45° field of view: 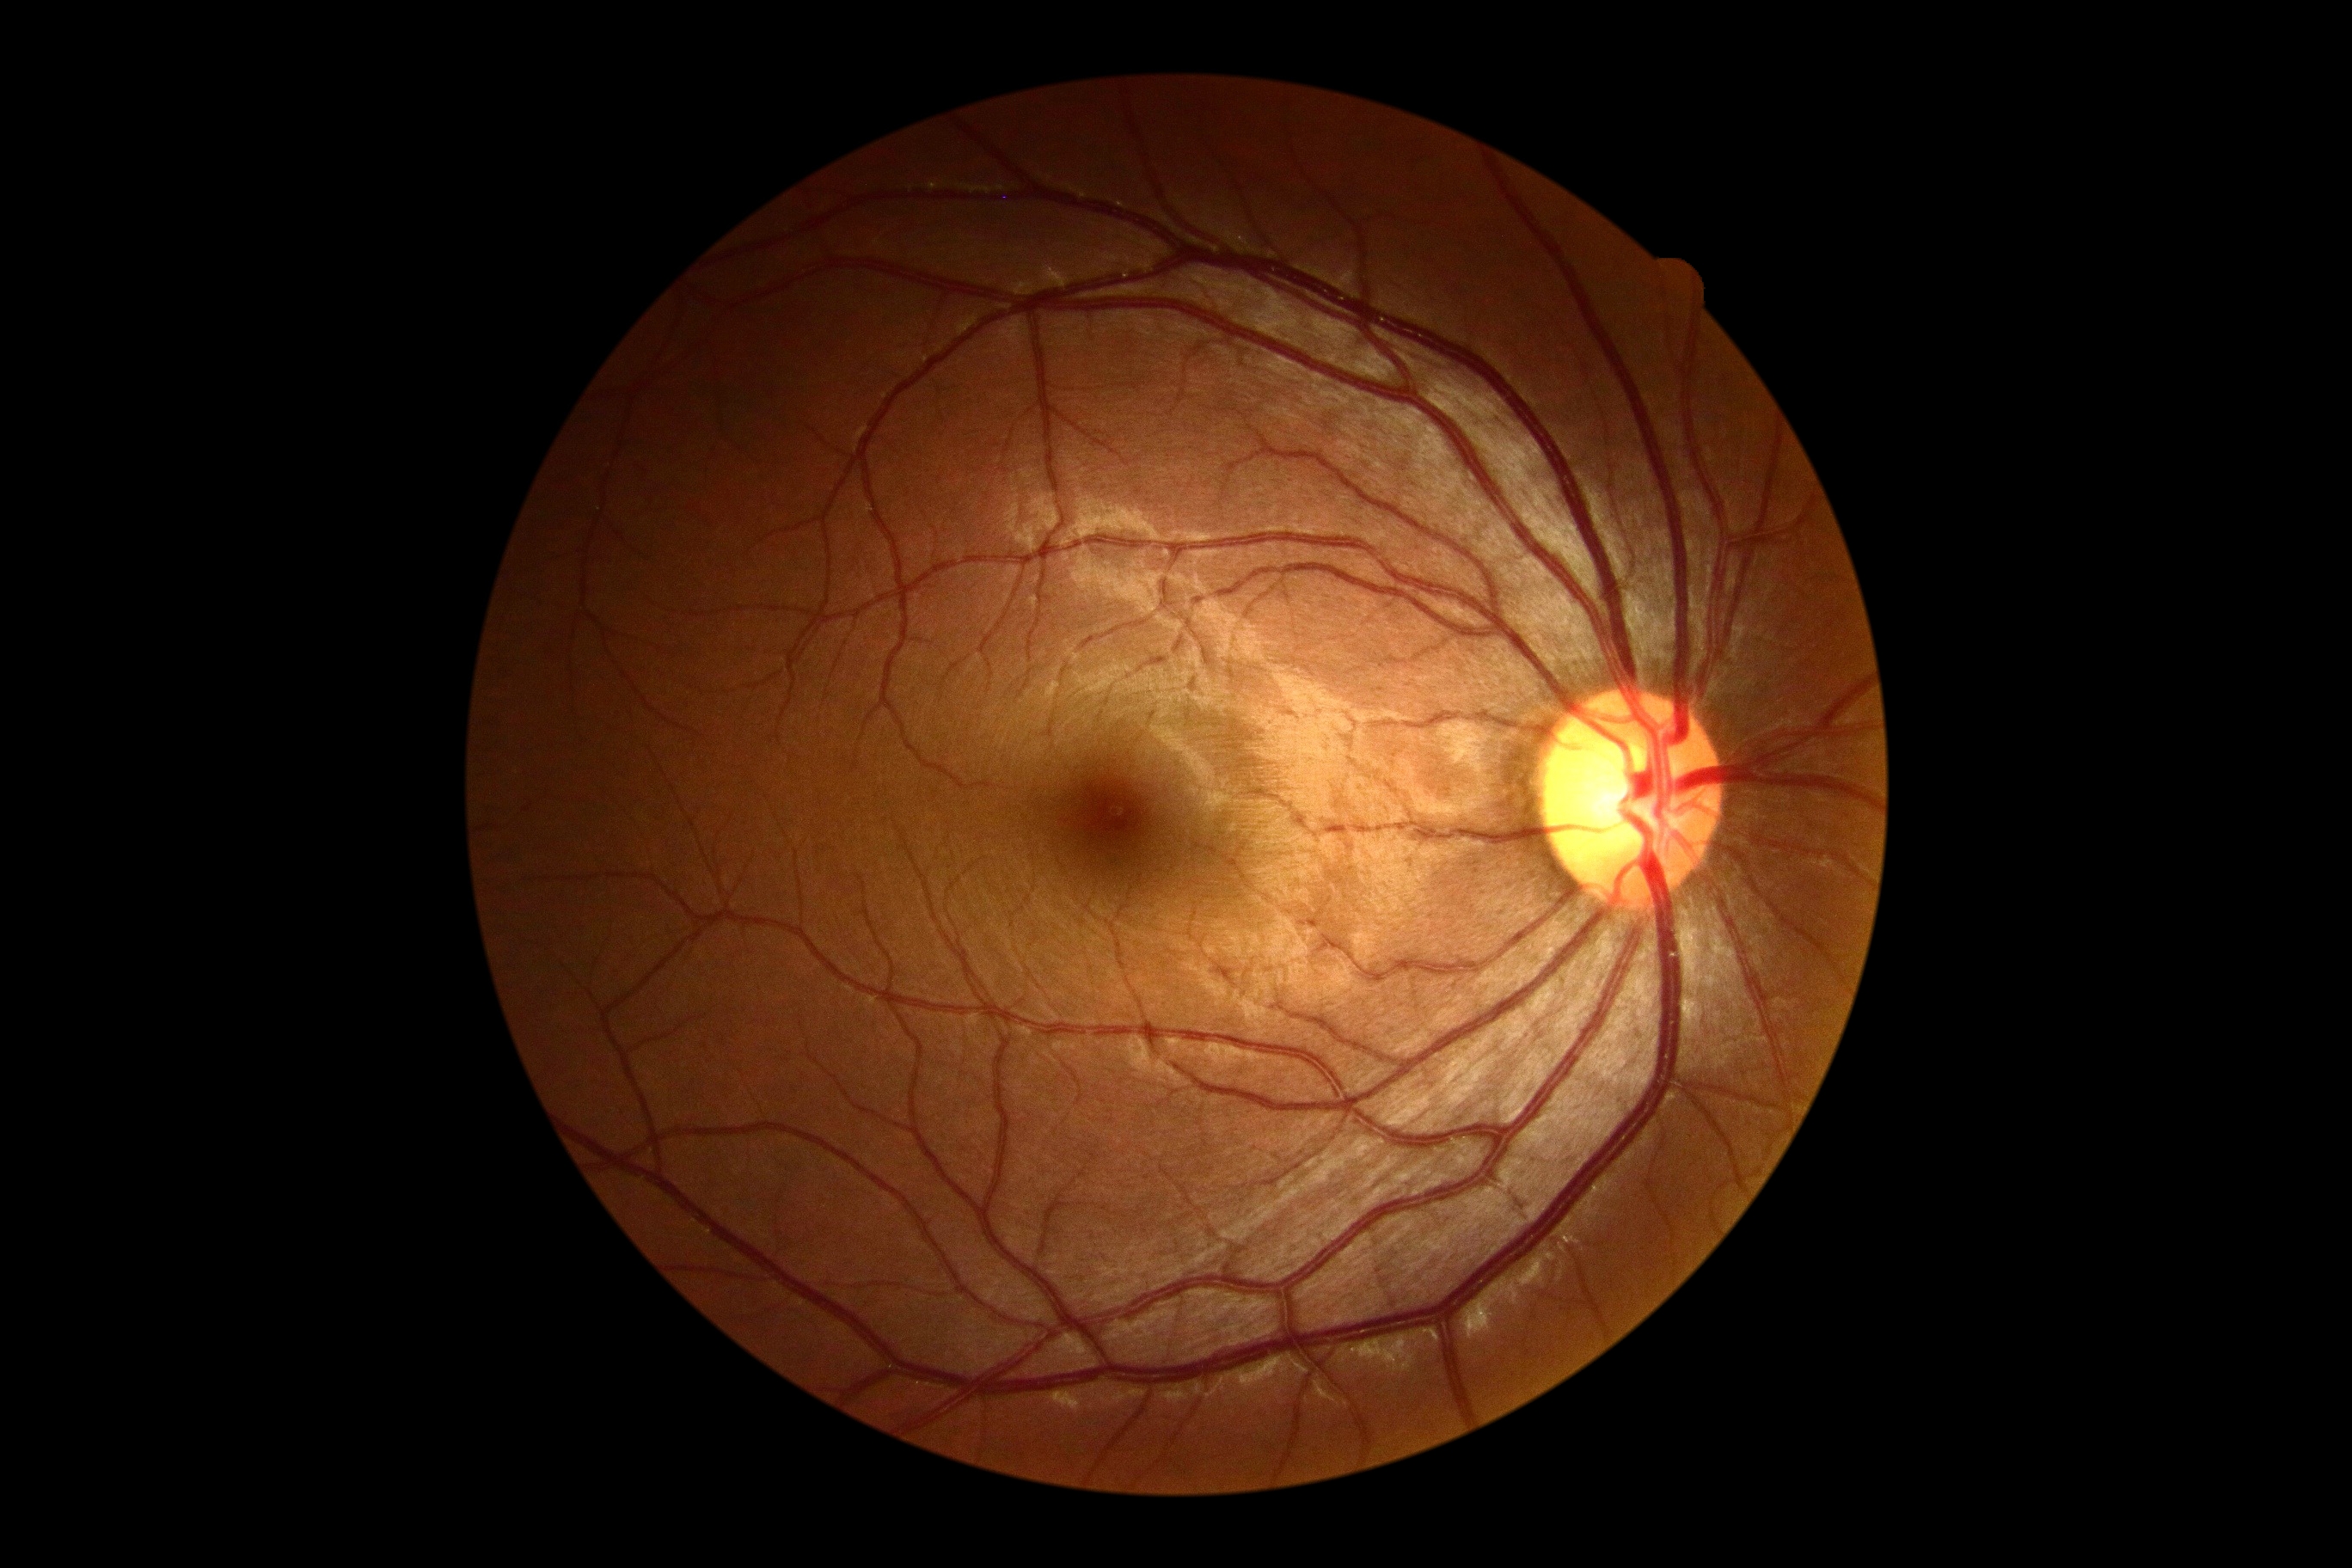 DR stage: grade 0 (no apparent retinopathy). No diabetic retinal disease findings.